FOV: 45 degrees
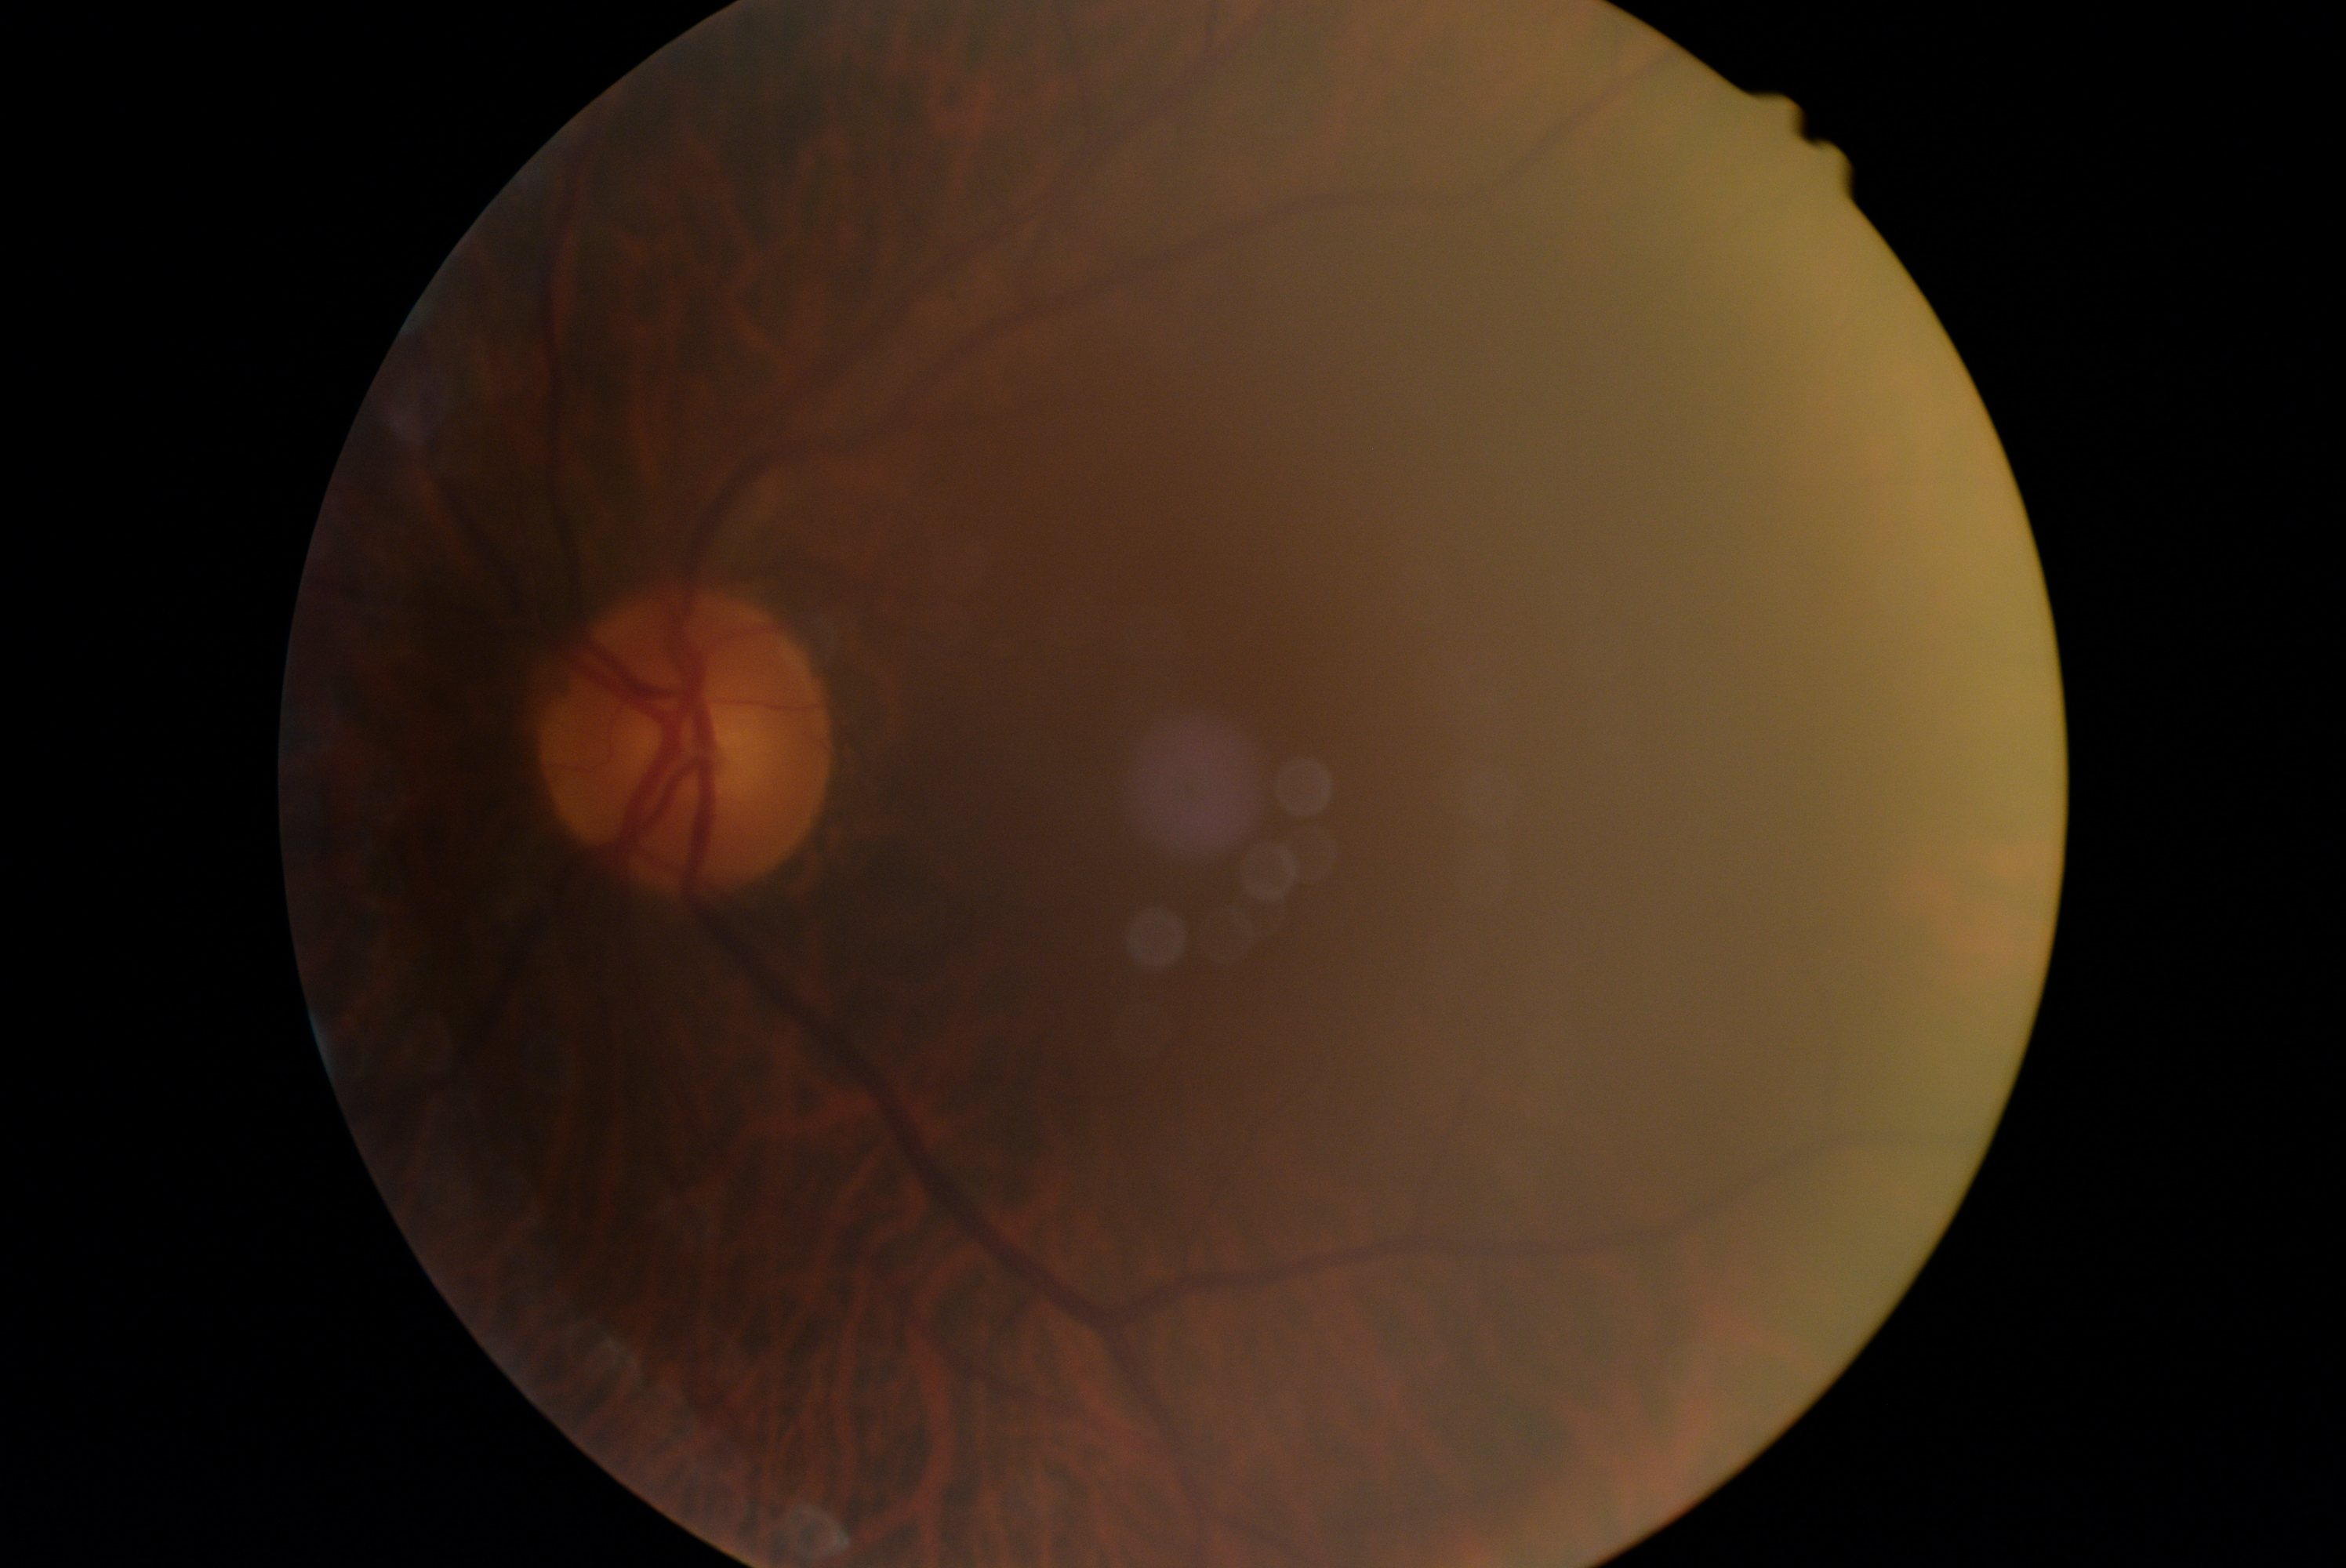 Diabetic retinopathy grade: 0 (no apparent retinopathy). No apparent diabetic retinopathy.